CFP
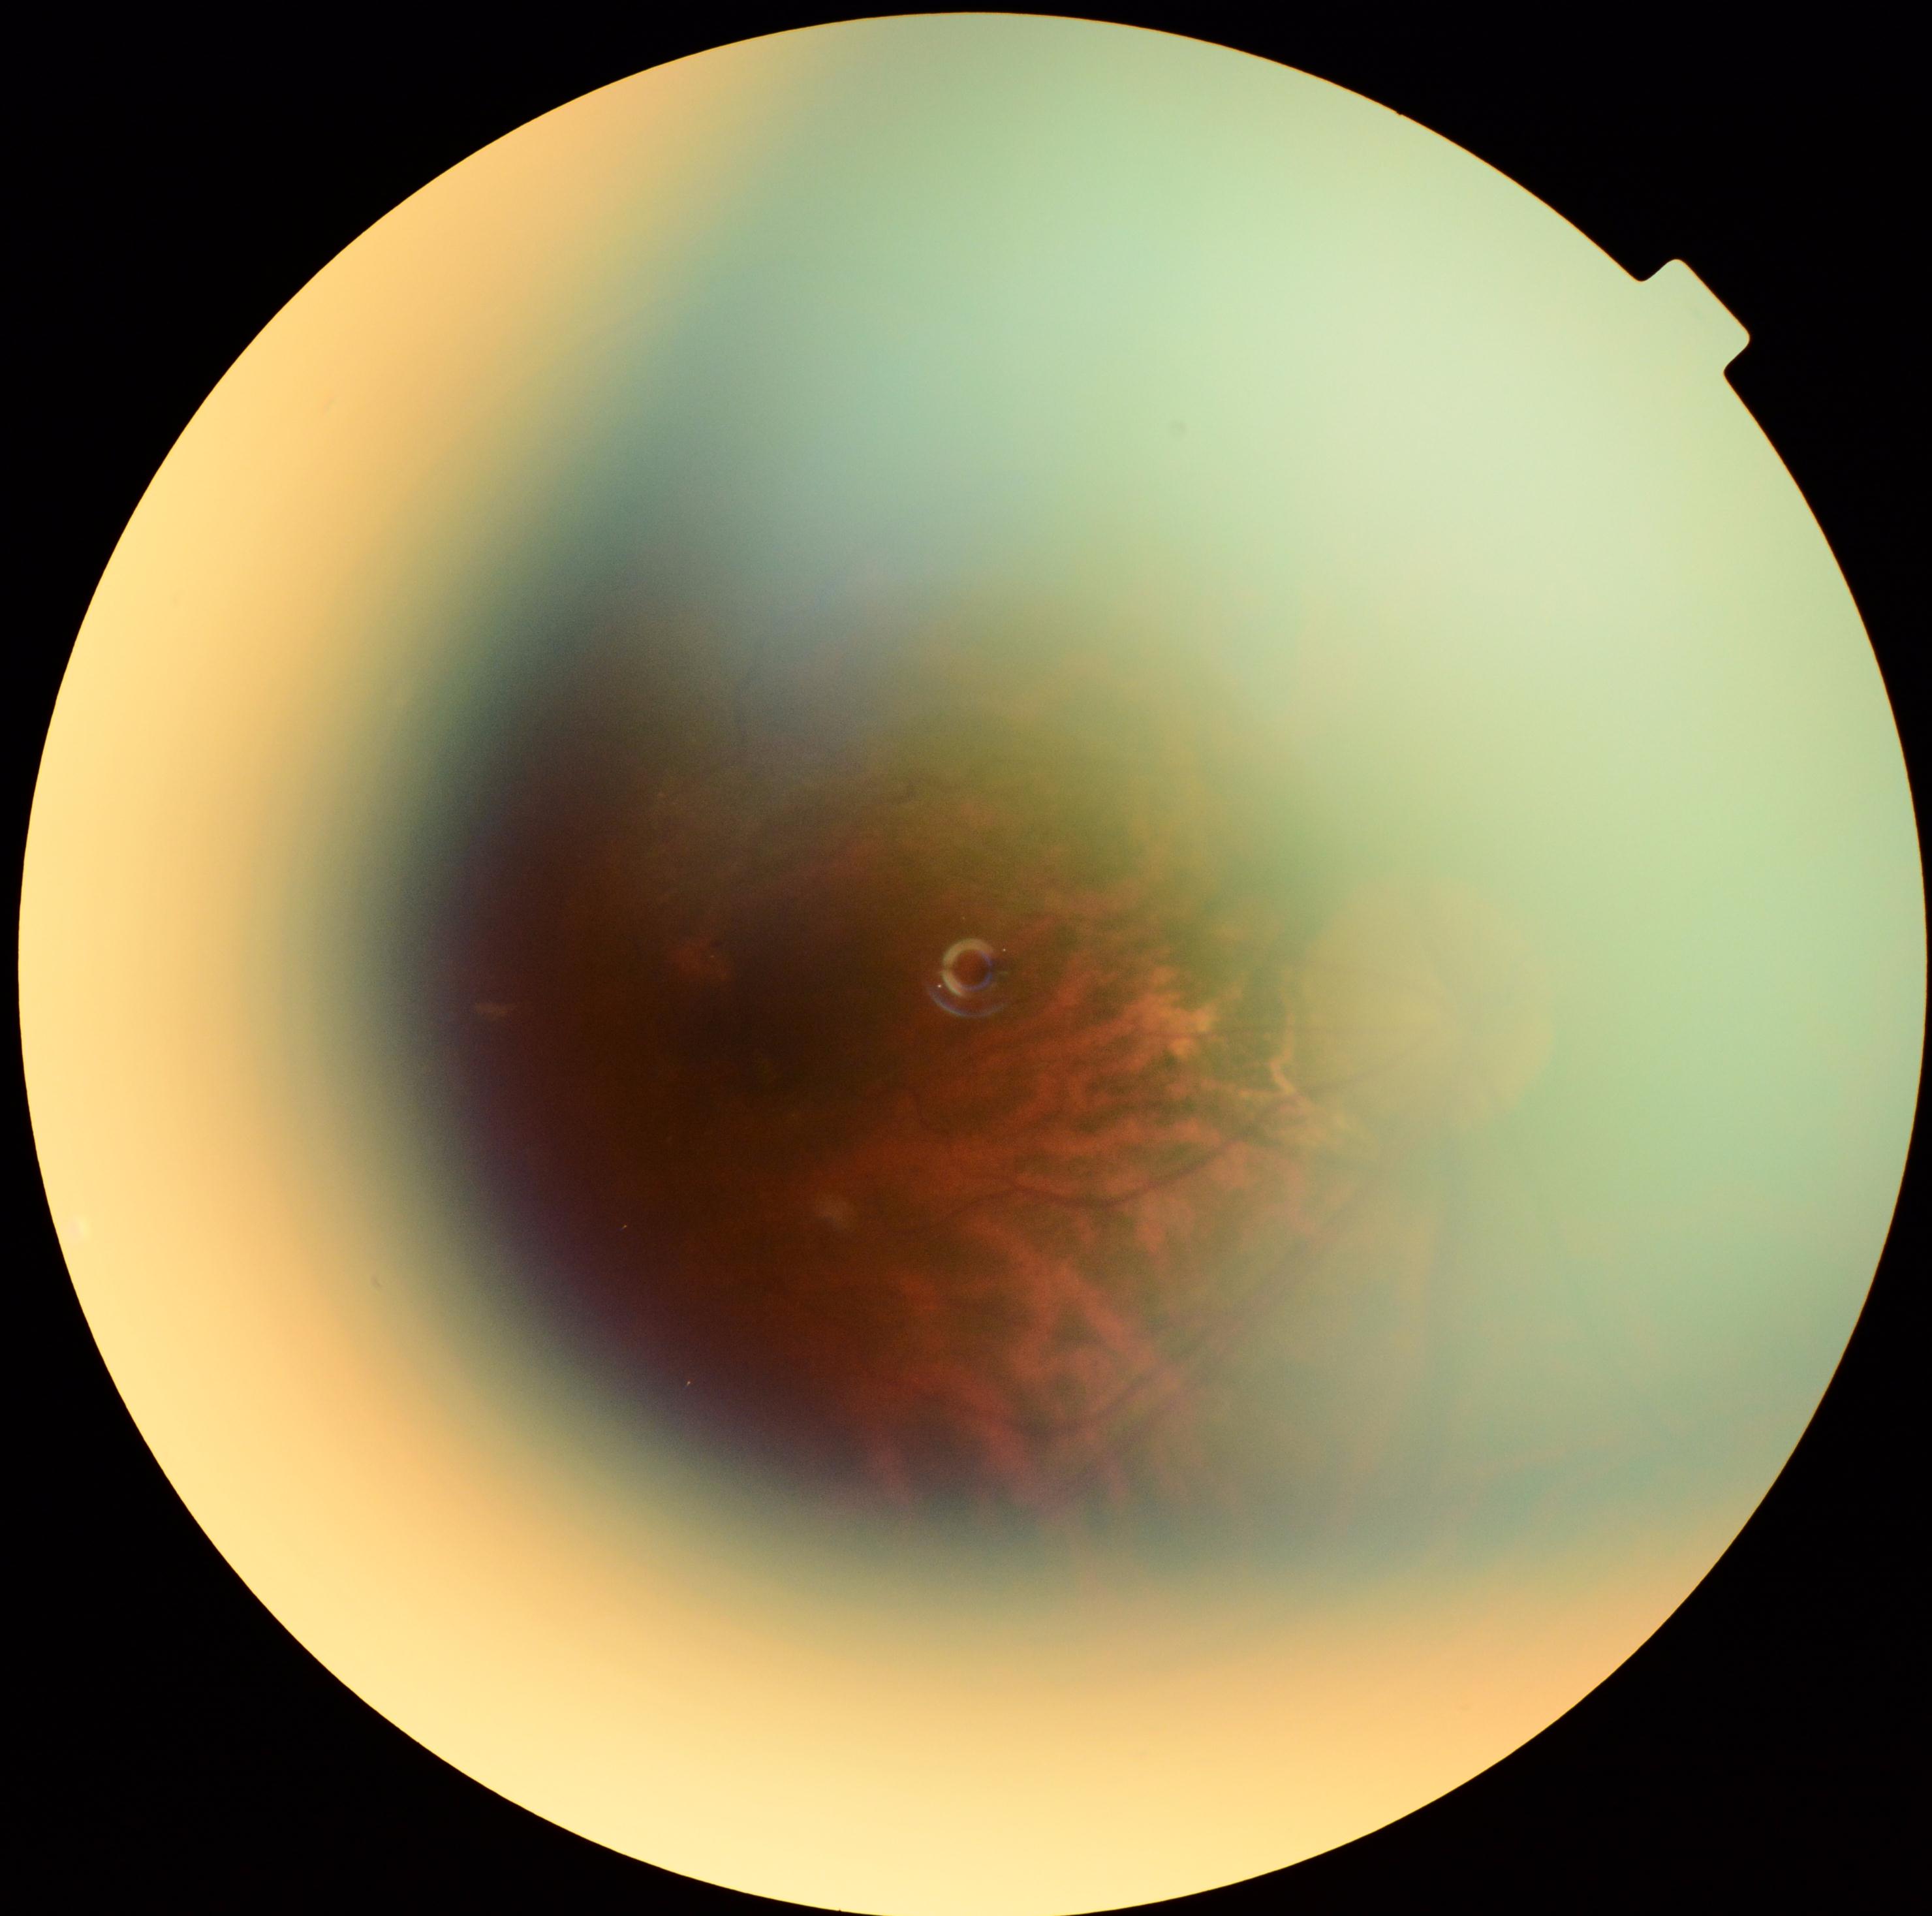

Diabetic retinopathy (DR) is ungradable.